Wide-field fundus photograph from neonatal ROP screening: 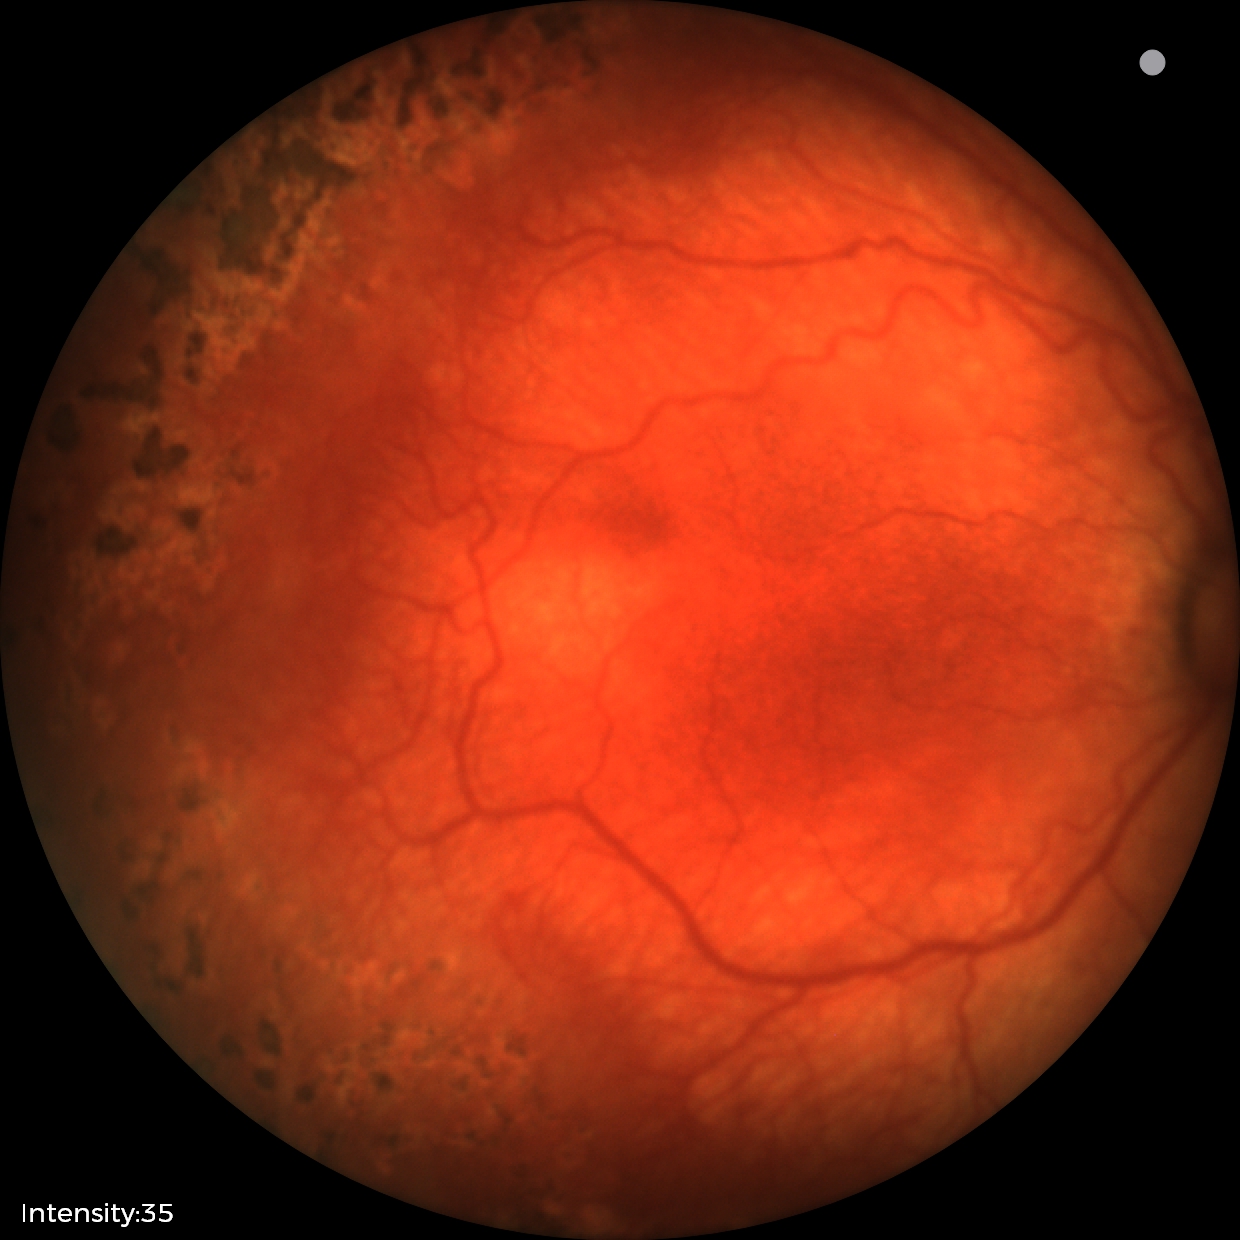 Plus disease present.
Examination diagnosed as retinopathy of prematurity (ROP) stage 1.